Image size 2352x1568:
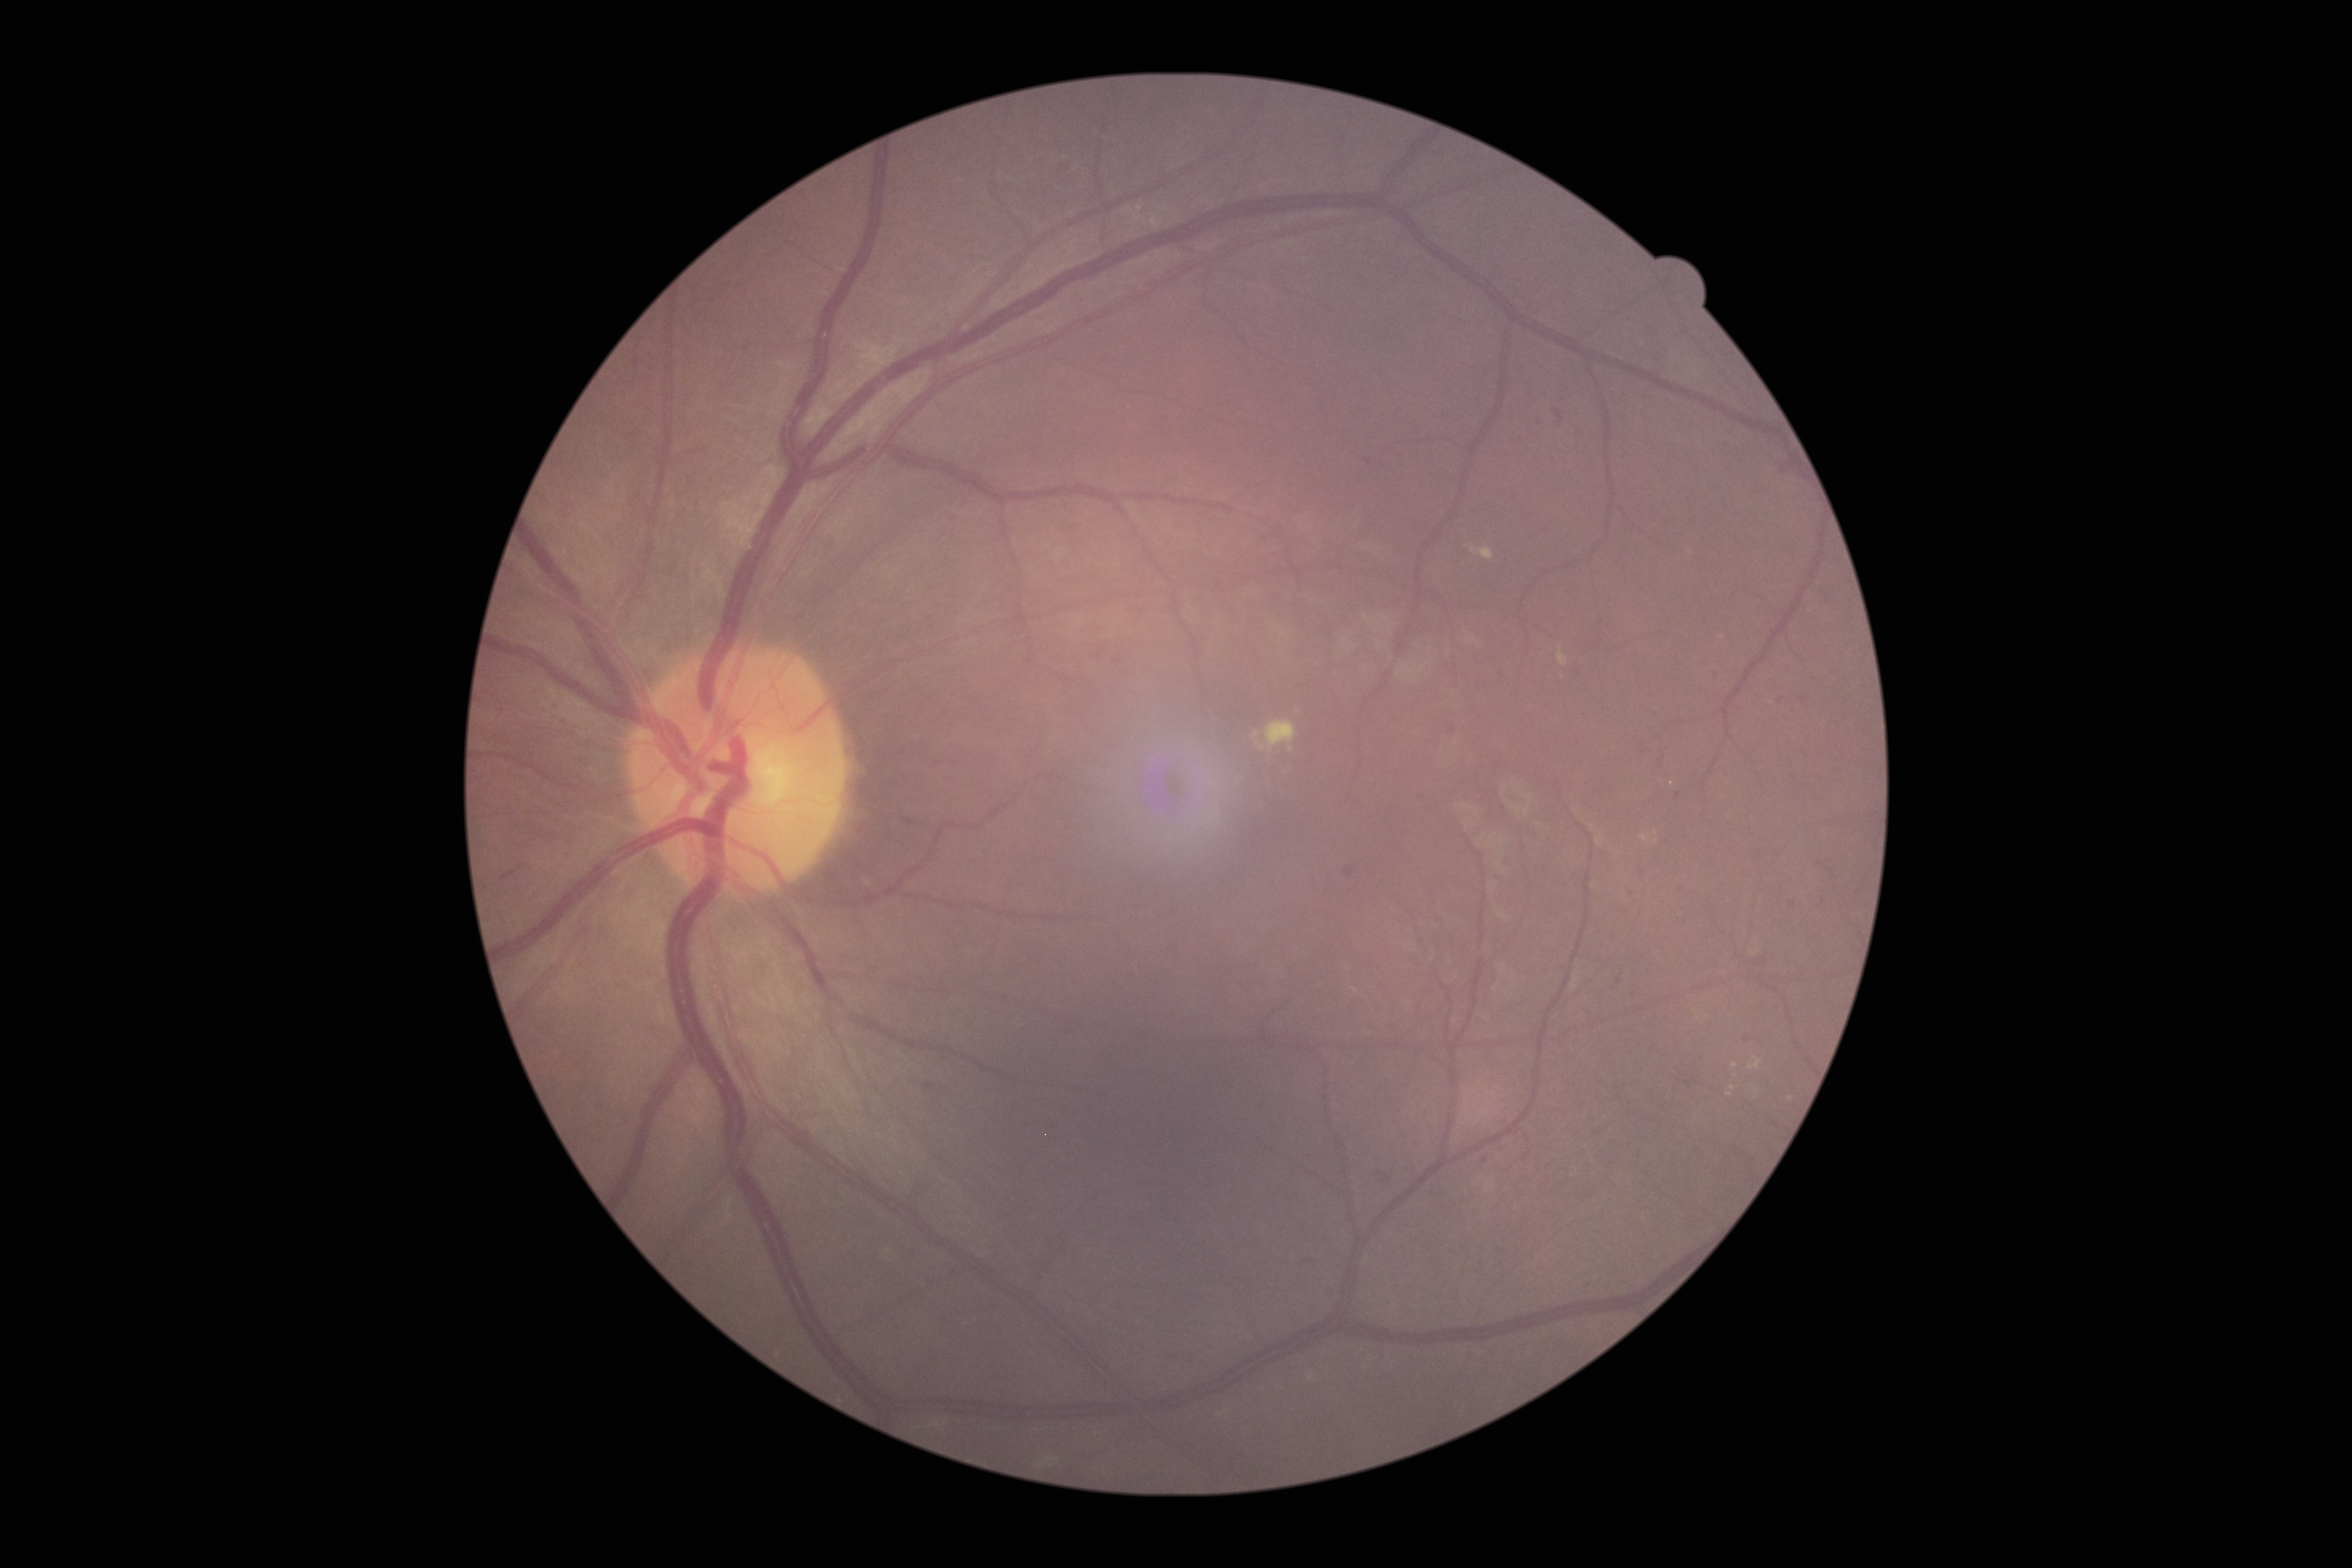
The retinopathy is classified as non-proliferative diabetic retinopathy.
DR stage is 2.